2352x1568
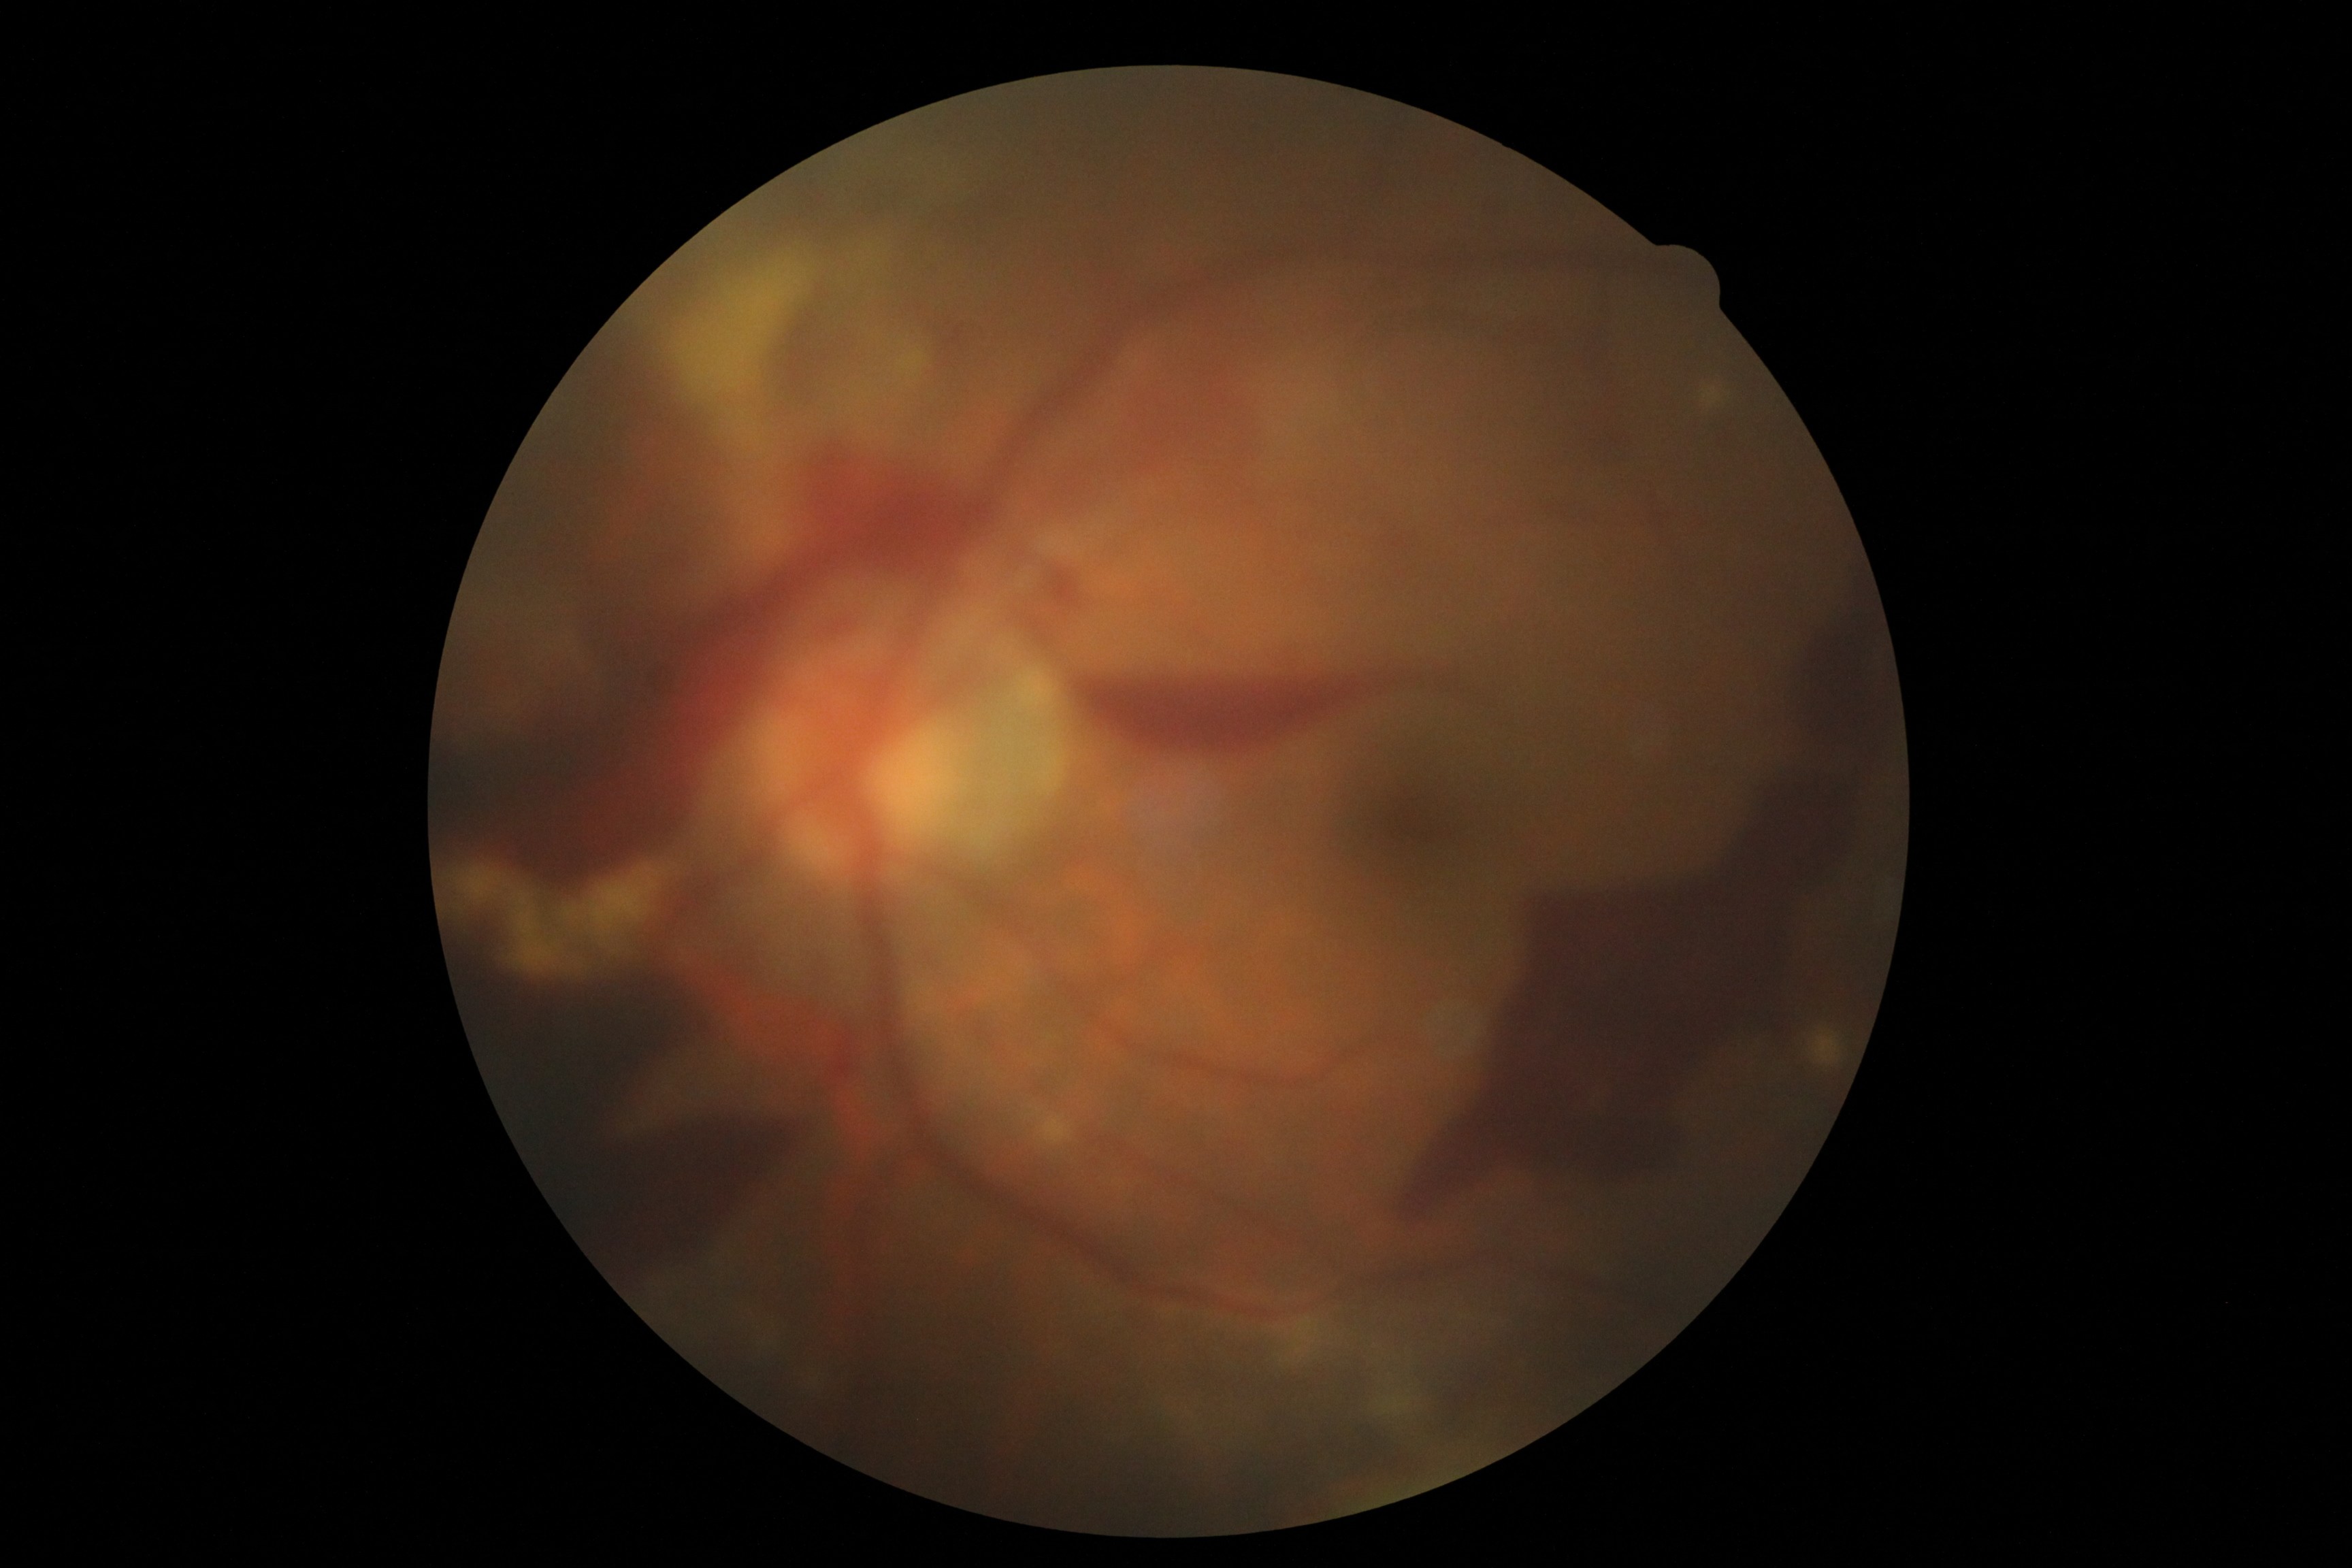
  dr_category: proliferative diabetic retinopathy
  dr_grade: grade 4 (PDR)